No pharmacologic dilation:
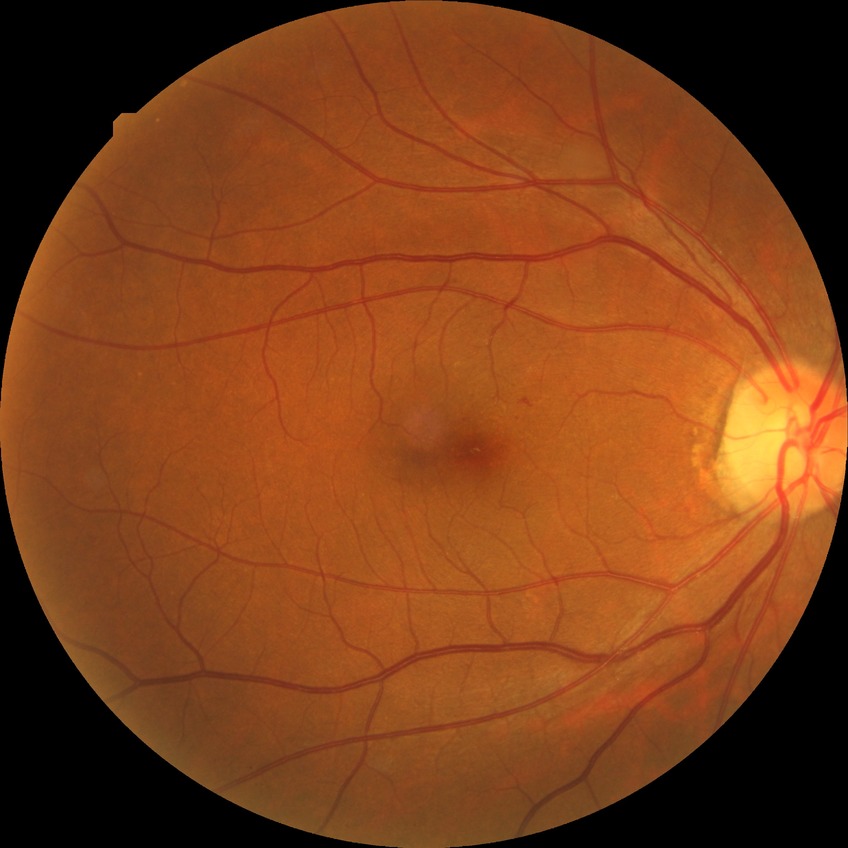

Diabetic retinopathy (DR): NDR (no diabetic retinopathy).